Acquired with a NIDEK AFC-230:
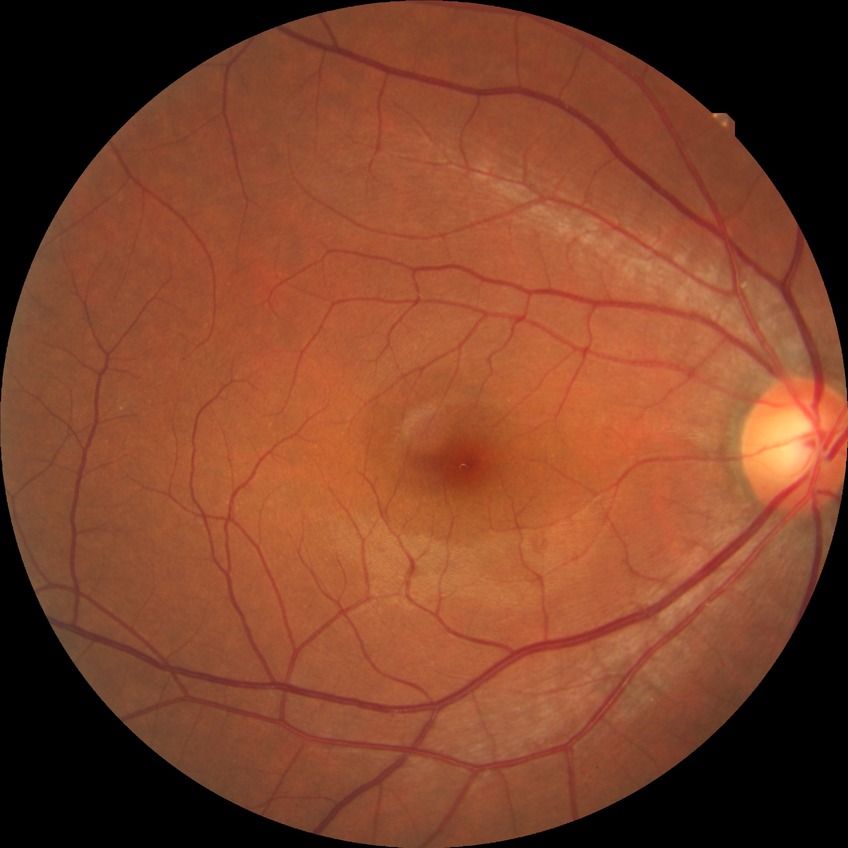 Annotations:
- DR: NDR